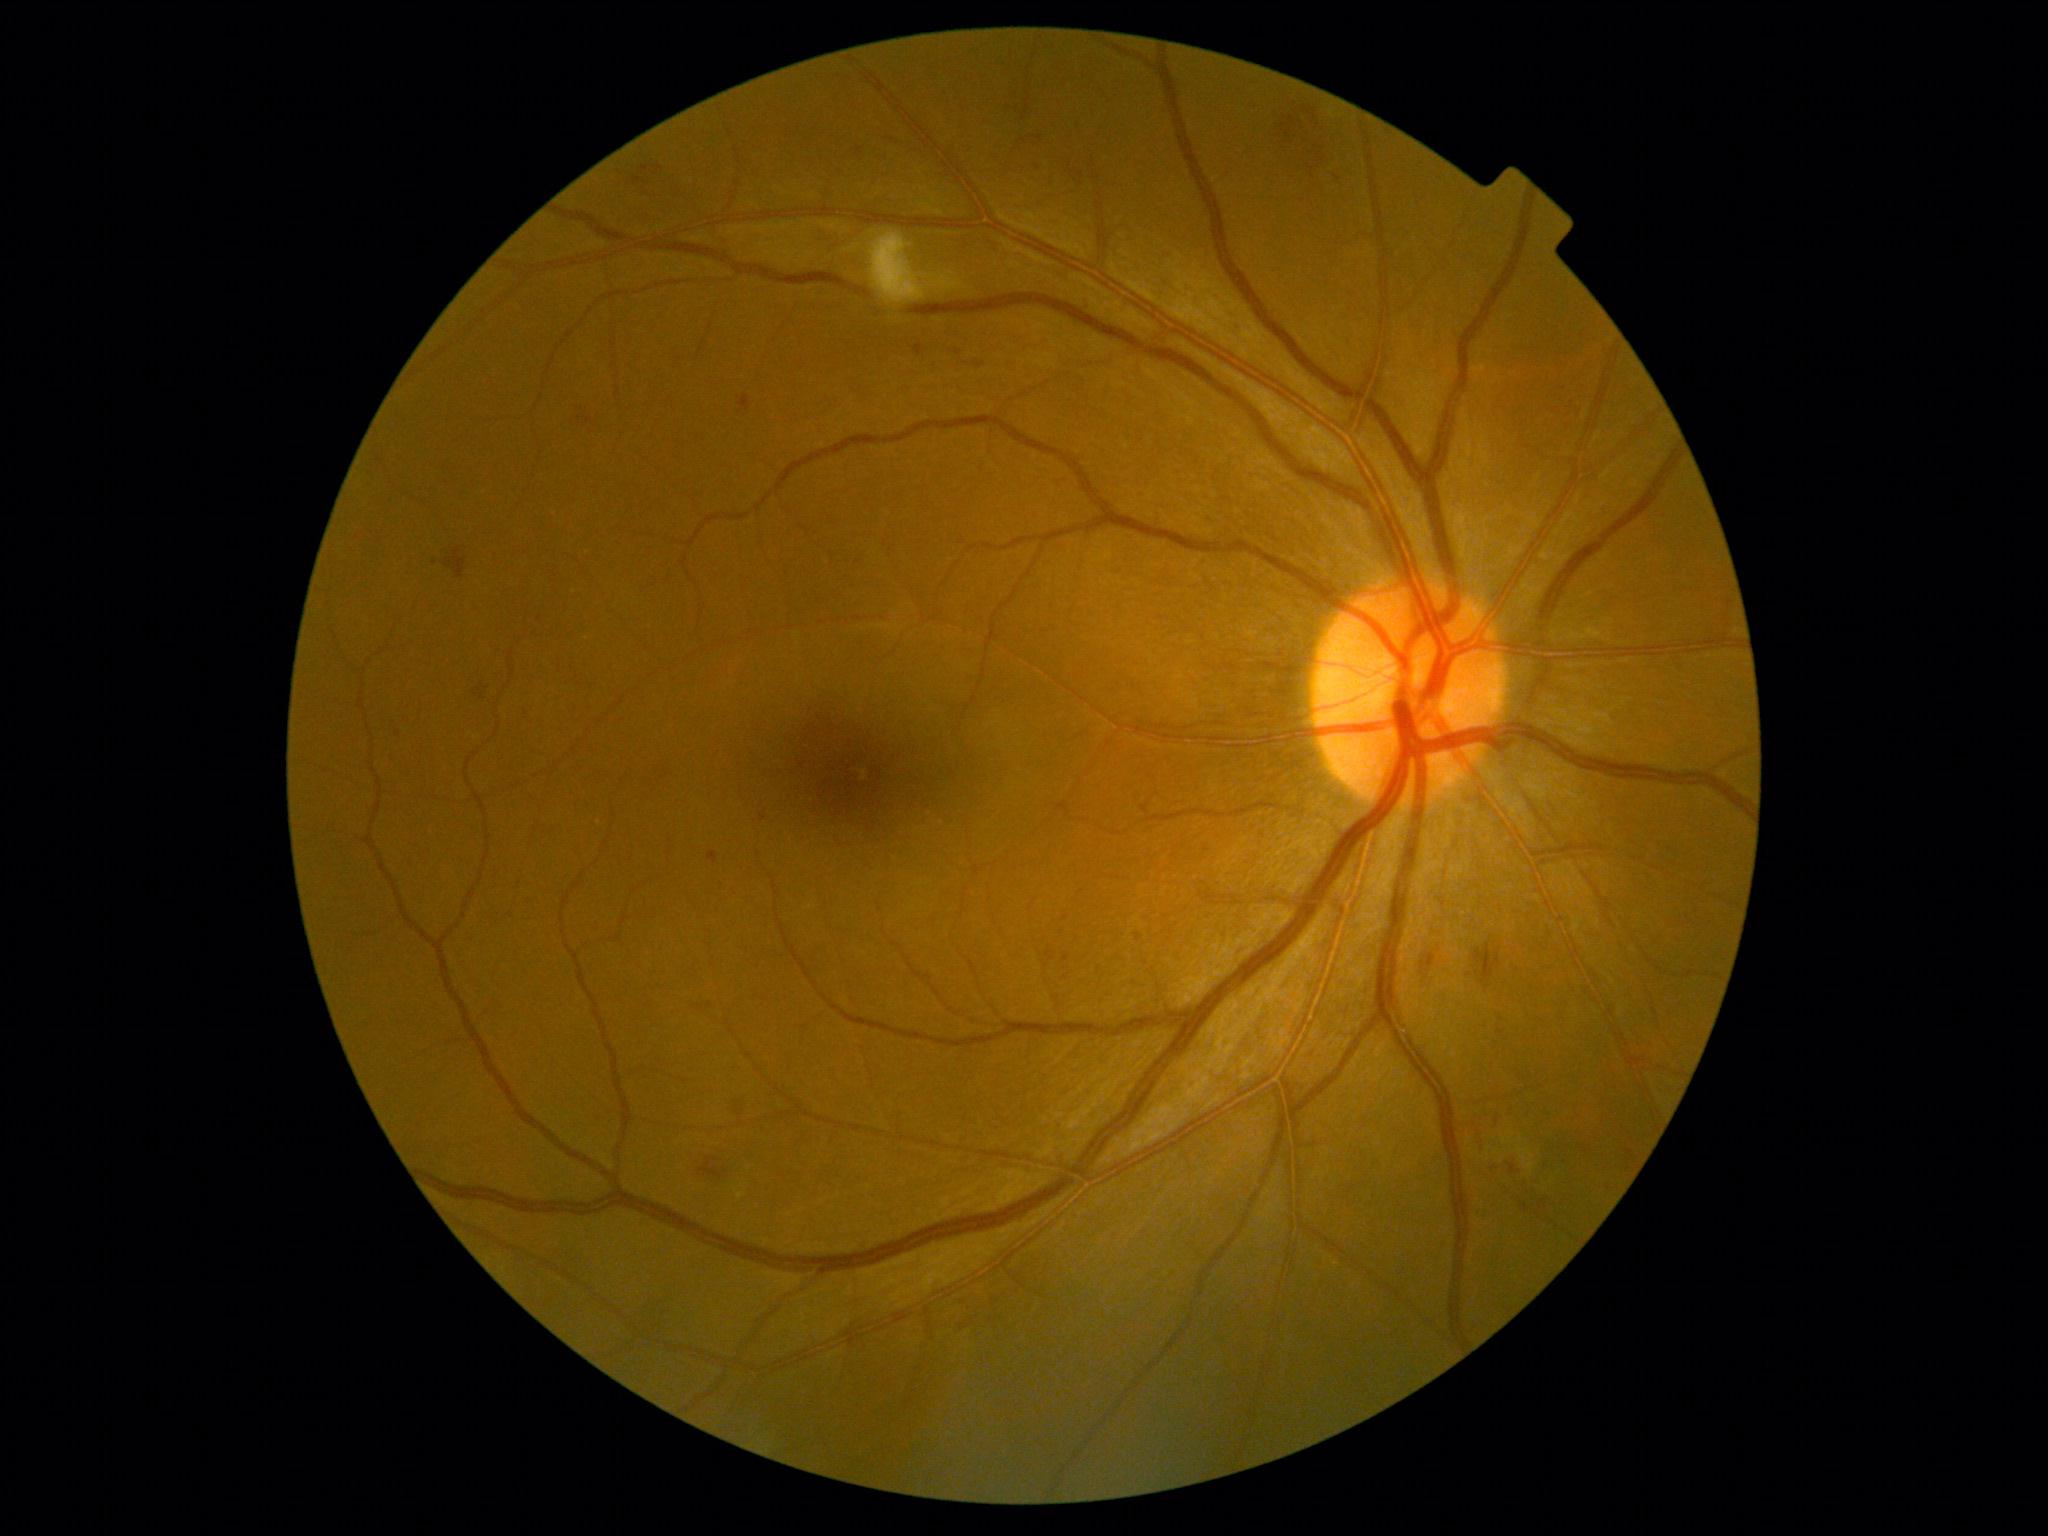

Diabetic retinopathy (DR): 2/4 — more than just microaneurysms but less than severe NPDR. Soft exudates (SEs) present at (1486,1147,1491,1156) | (1494,1148,1503,1156) | (1501,1131,1516,1146) | (1467,1138,1471,1146) | (1470,1149,1480,1156) | (1519,1134,1525,1144) | (1512,1146,1535,1175) | (737,1193,746,1199) | (870,232,966,304). Small SEs approximately at (953; 274). Hemorrhages (HEs) present at (695,1153,734,1185) | (1275,100,1328,180) | (1467,944,1501,996) | (444,549,467,579). Microaneurysms (MAs) include those at (731,1092,749,1118) | (974,361,985,369) | (695,1004,705,1012) | (1135,934,1144,941) | (708,852,718,865) | (740,396,750,413) | (473,680,487,704) | (632,175,642,186) | (857,147,863,157). Small MAs approximately at (1038; 168) | (1629; 1169) | (763; 817) | (1337; 178) | (709; 1005). No hard exudates (EXs) identified.